2352x1568
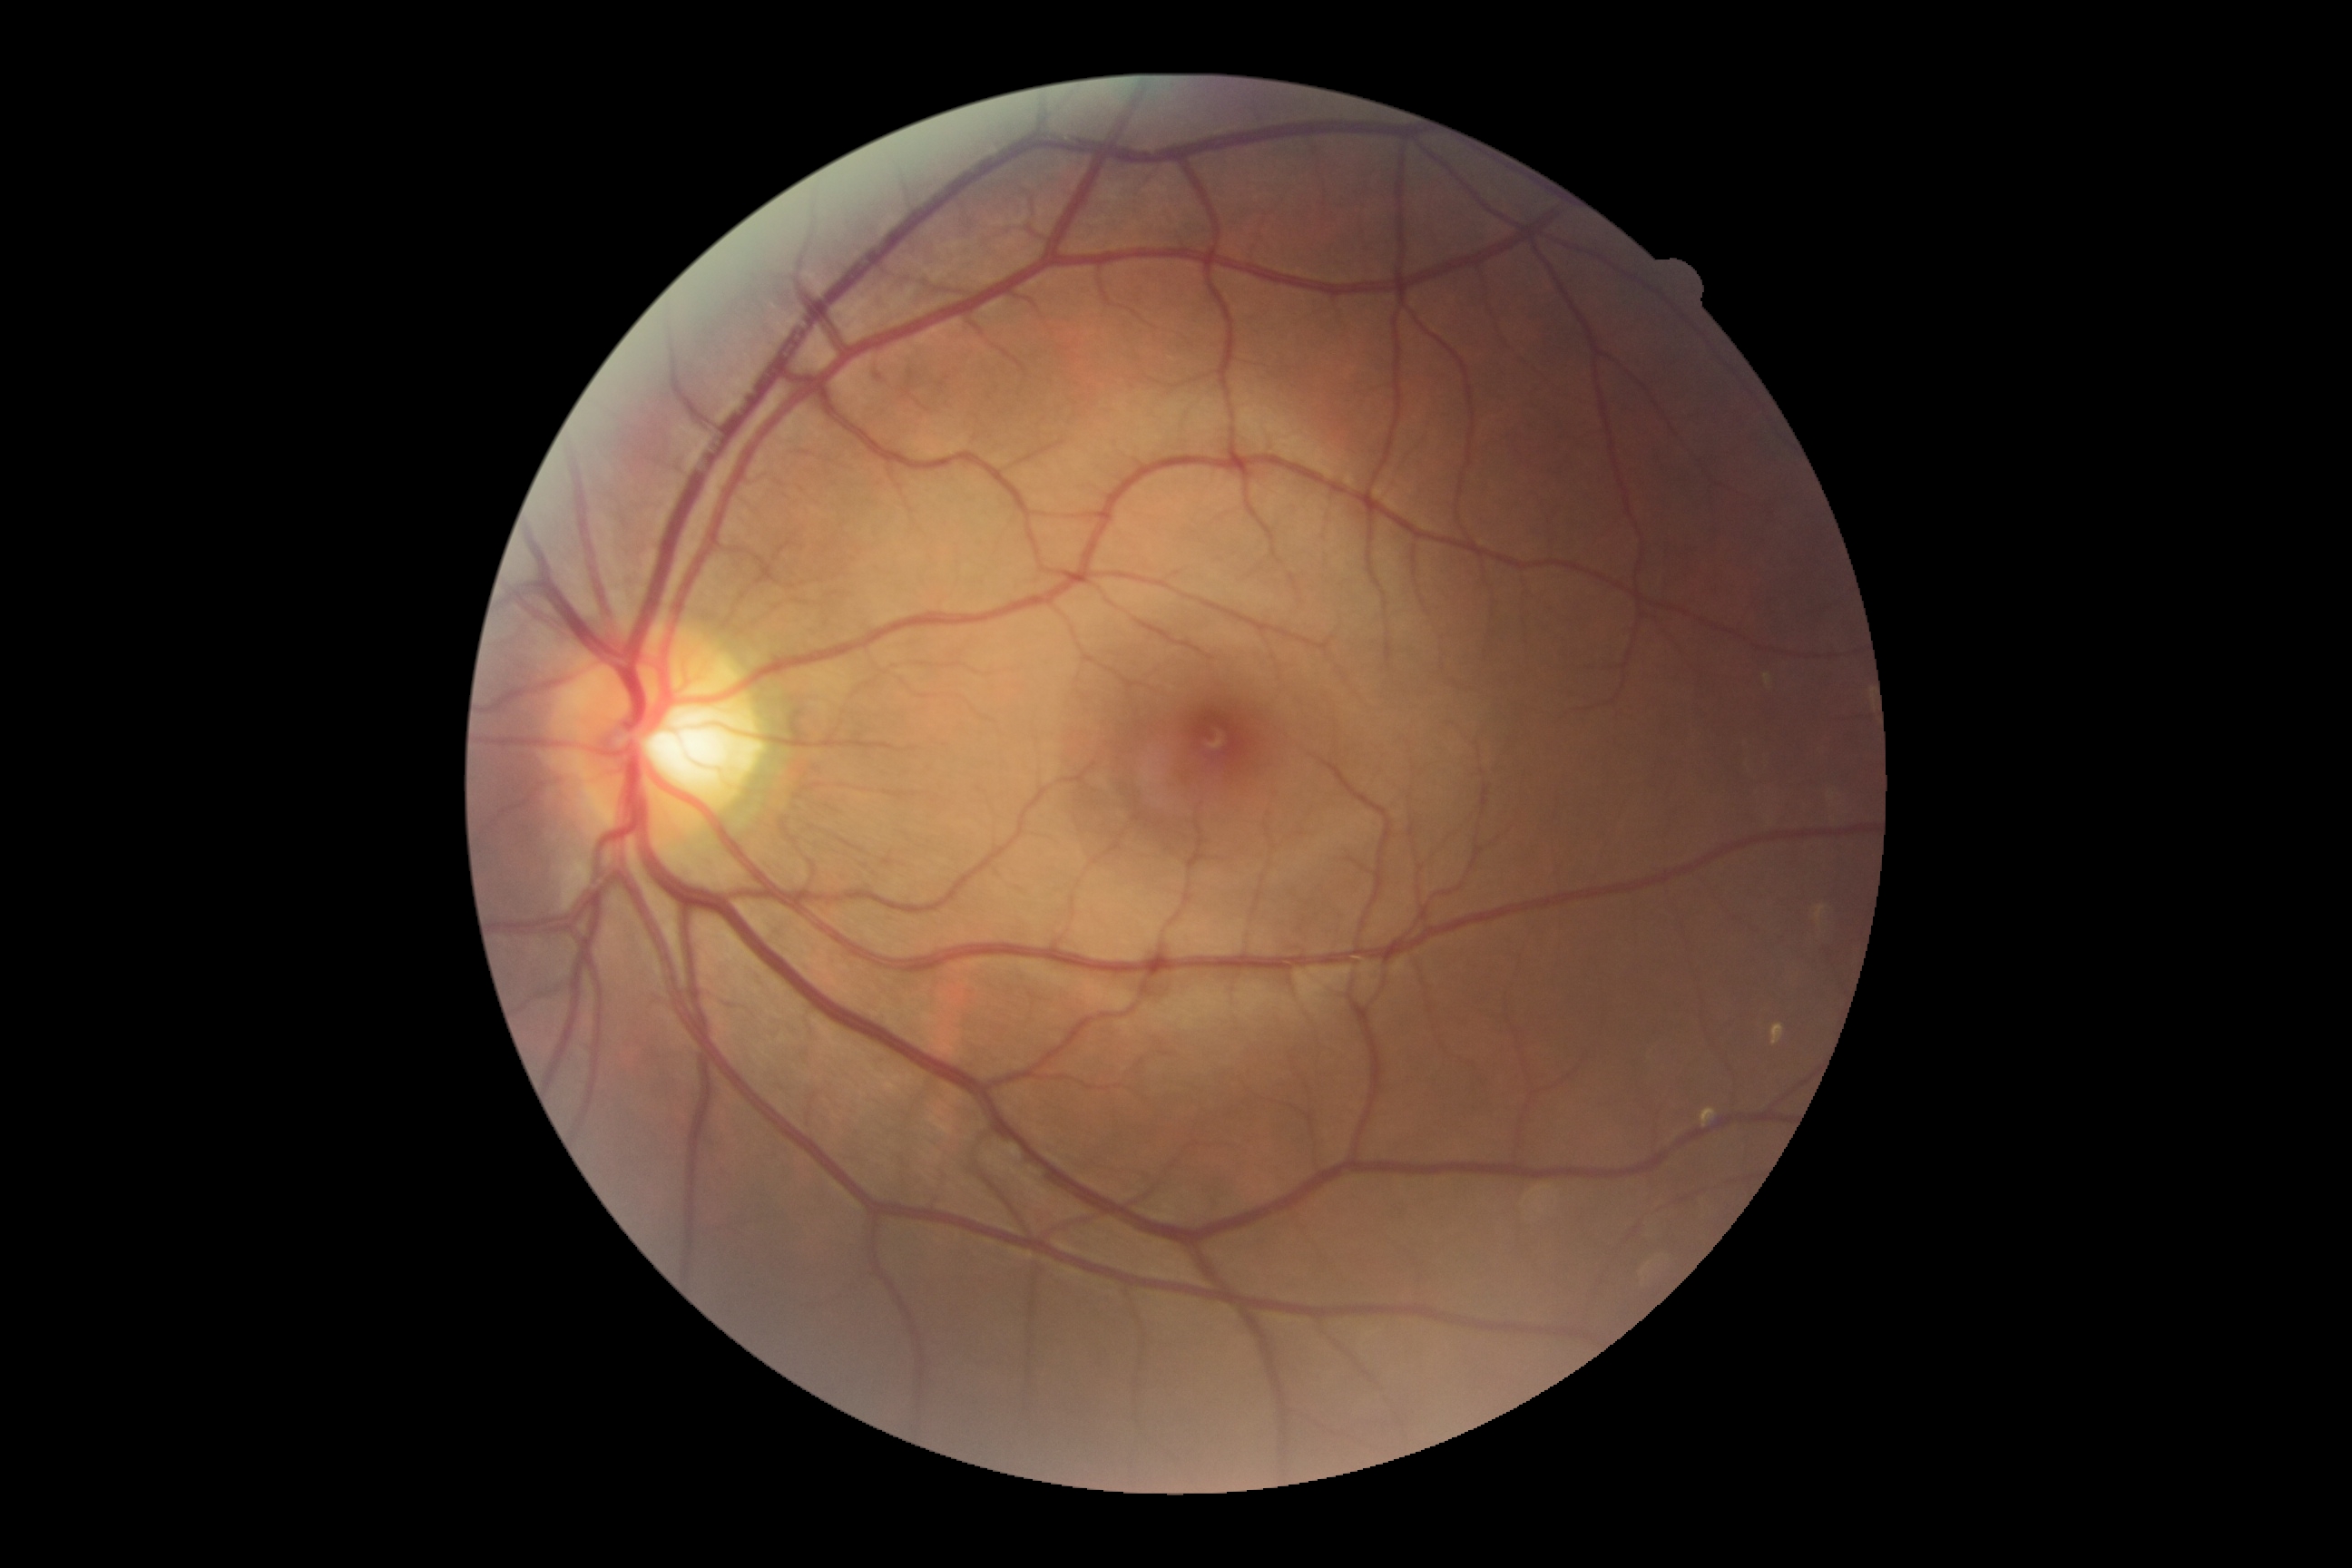

diabetic retinopathy = no apparent diabetic retinopathy (grade 0).